Axial length 23.96 mm. Patient age: 63 years. Central corneal thickness: 606 µm. Man patient: 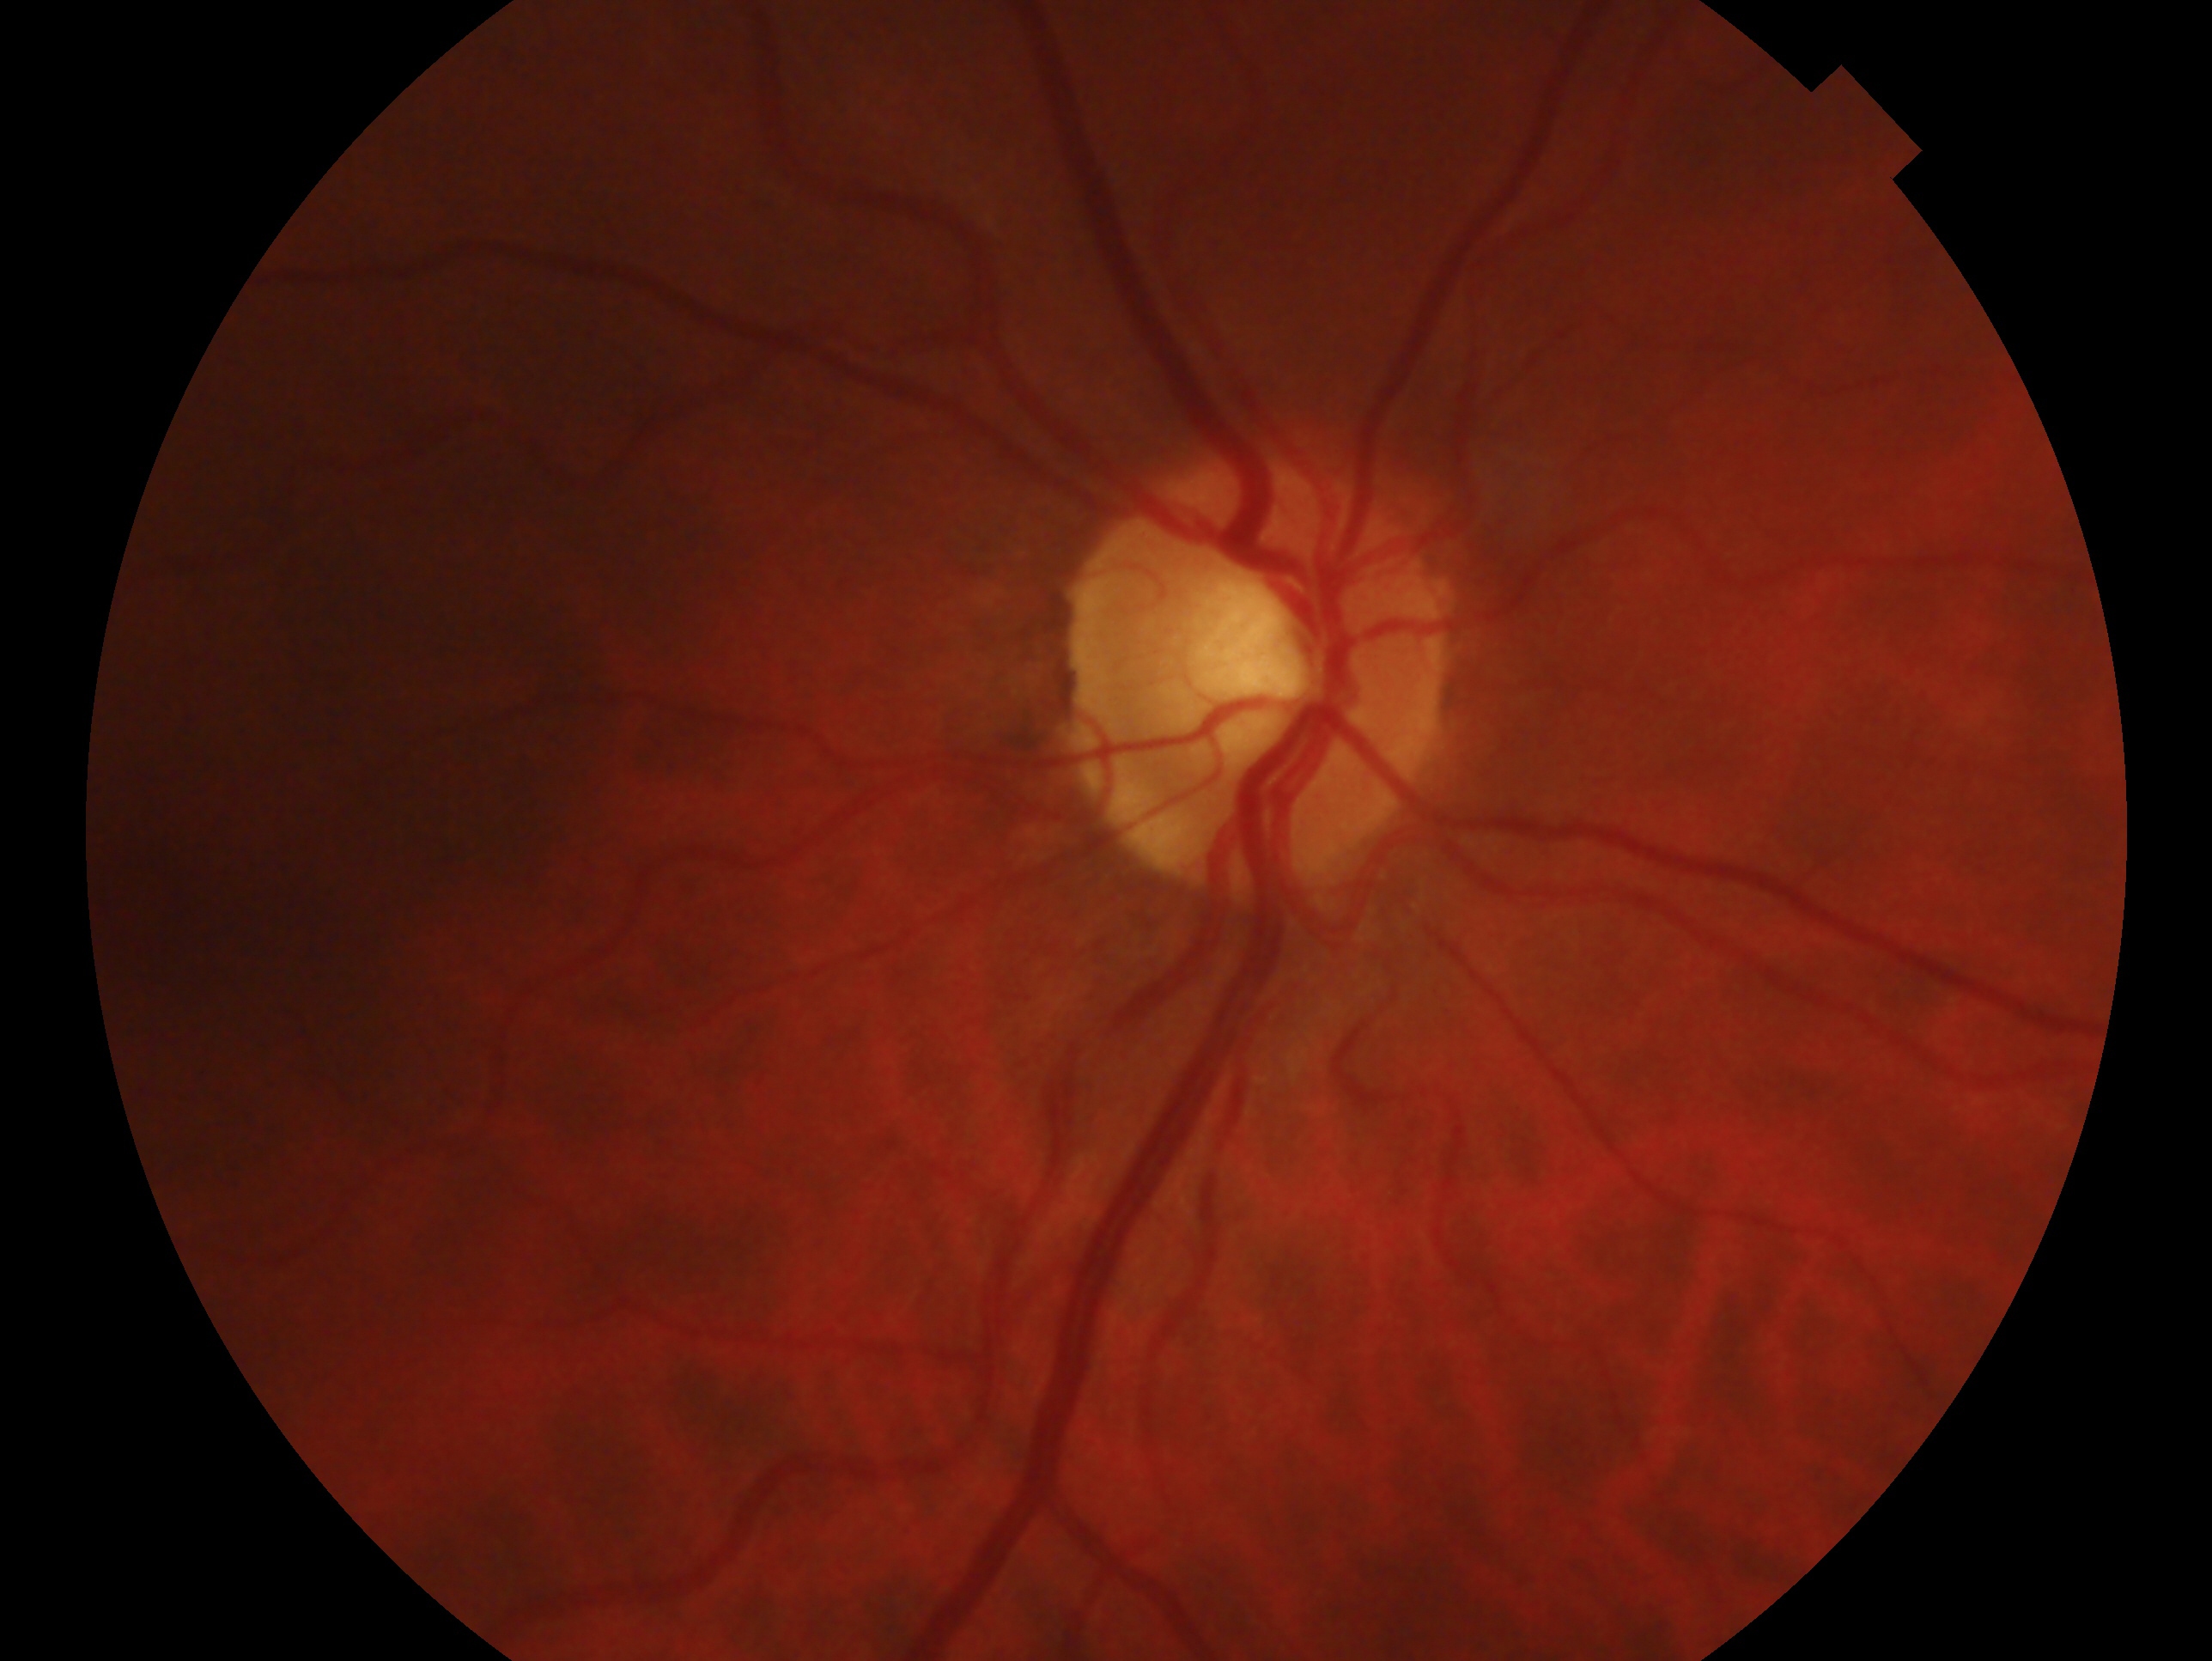 Glaucoma status: cannot be excluded — risk factors or equivocal findings for glaucoma without a confirmed diagnosis. This is the oculus dexter.